No pharmacologic dilation · 848 x 848 pixels · modified Davis classification:
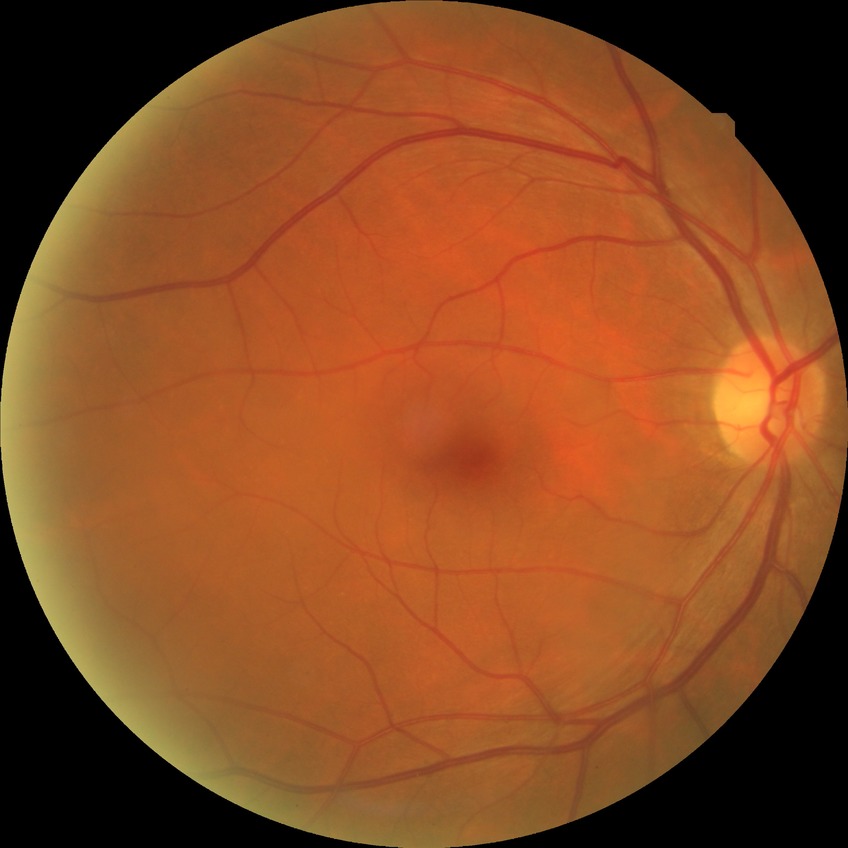
Diabetic retinopathy (DR) is no diabetic retinopathy (NDR).